45-degree field of view.
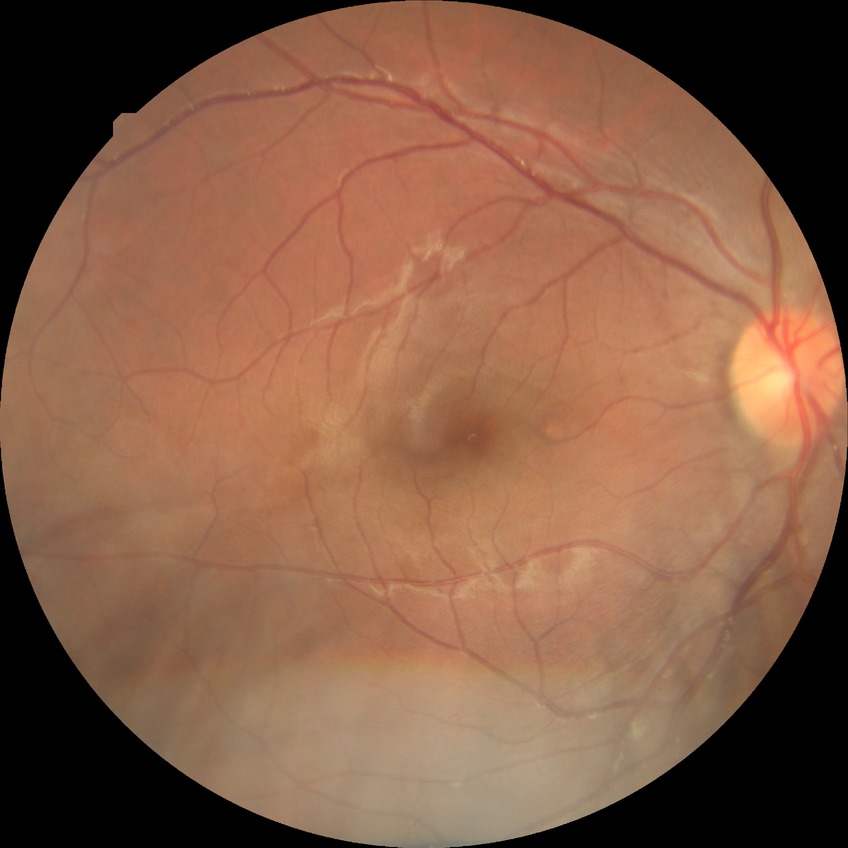 Davis grading: no diabetic retinopathy.